Image size 848x848. Posterior pole color fundus photograph. Nonmydriatic fundus photograph: 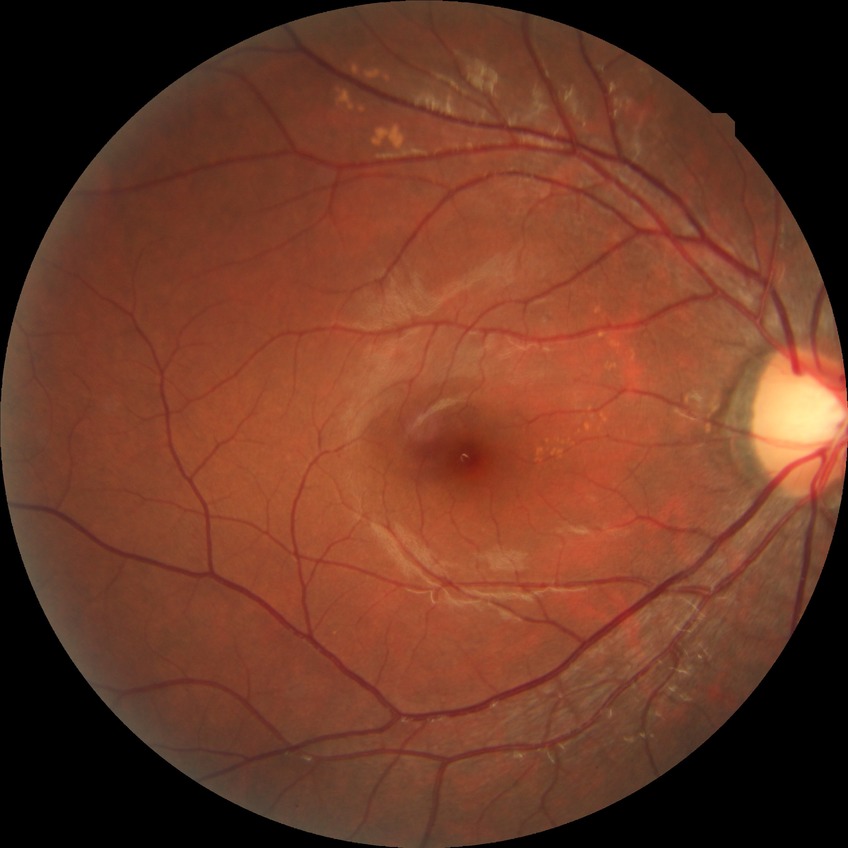
Modified Davis classification is no diabetic retinopathy.